640x480px · pediatric wide-field fundus photograph
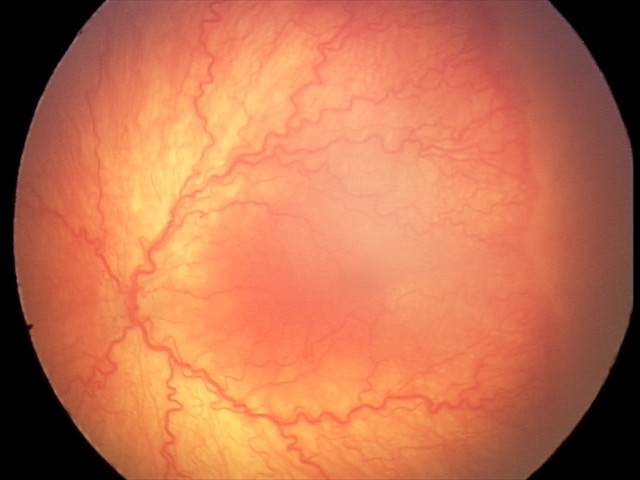 Examination diagnosed as aggressive retinopathy of prematurity. With plus disease.